2212 by 1659 pixels · 45-degree field of view.
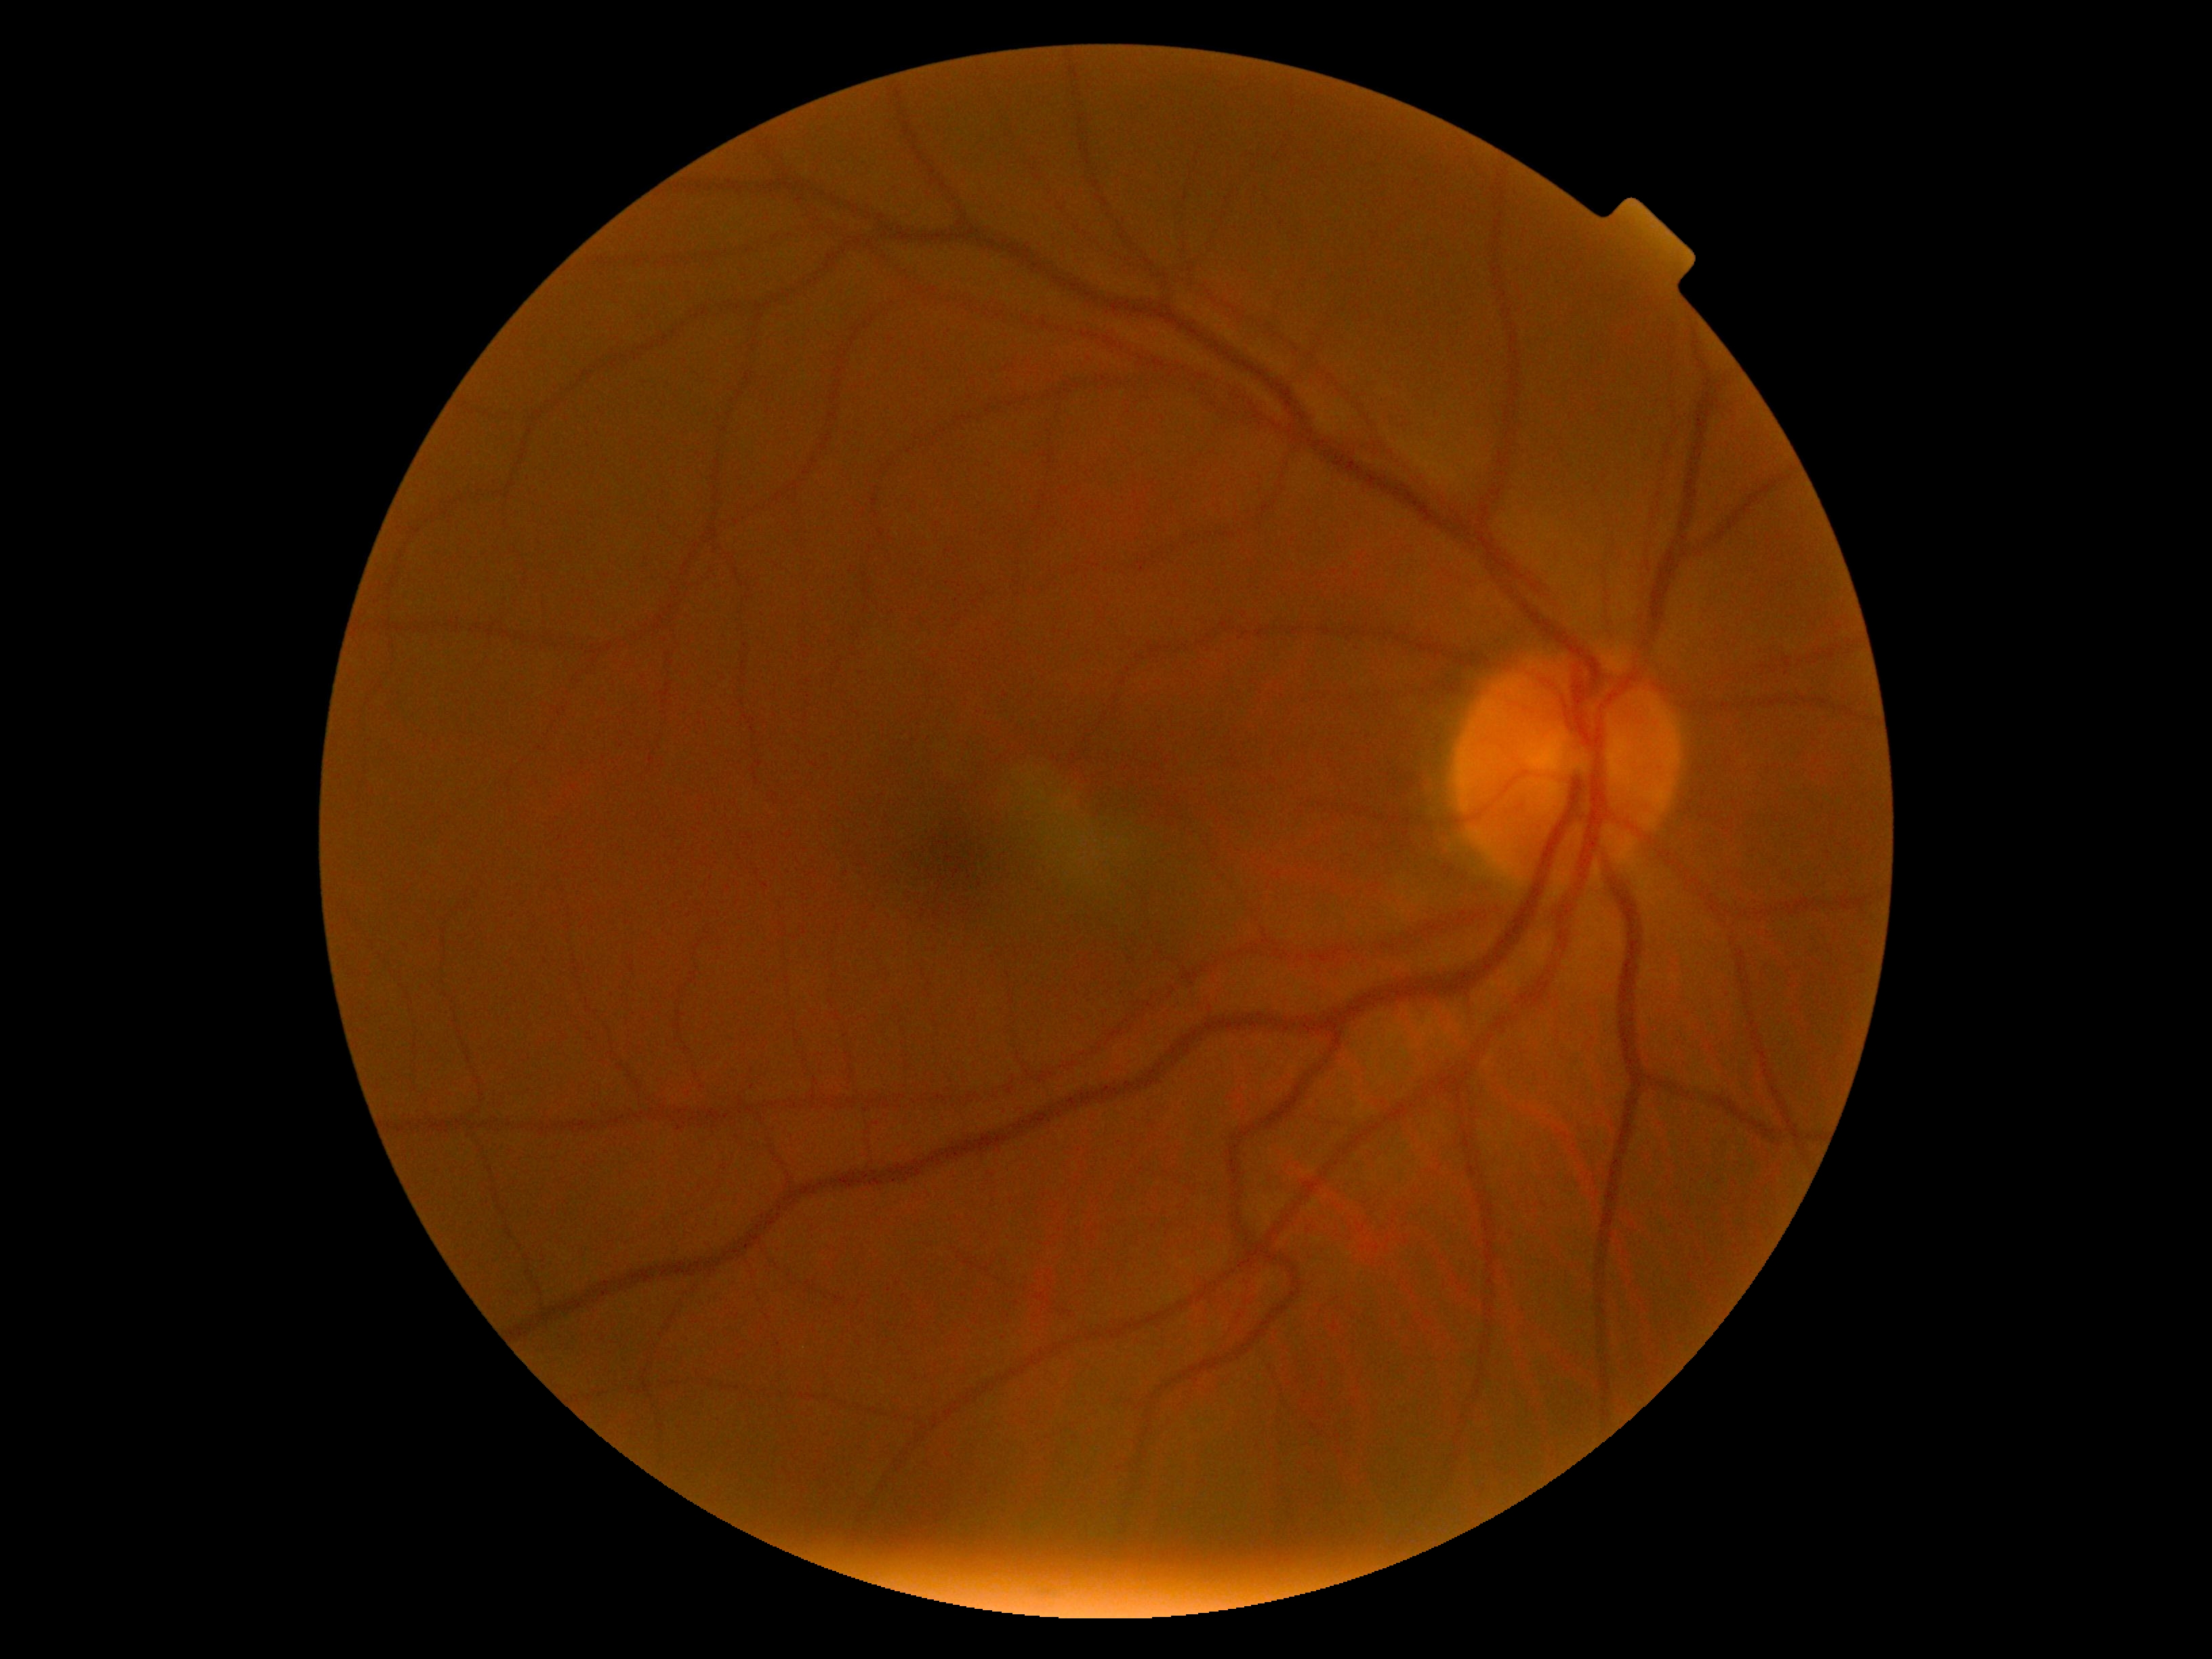

DR impression=negative for DR; diabetic retinopathy (DR)=grade 0.